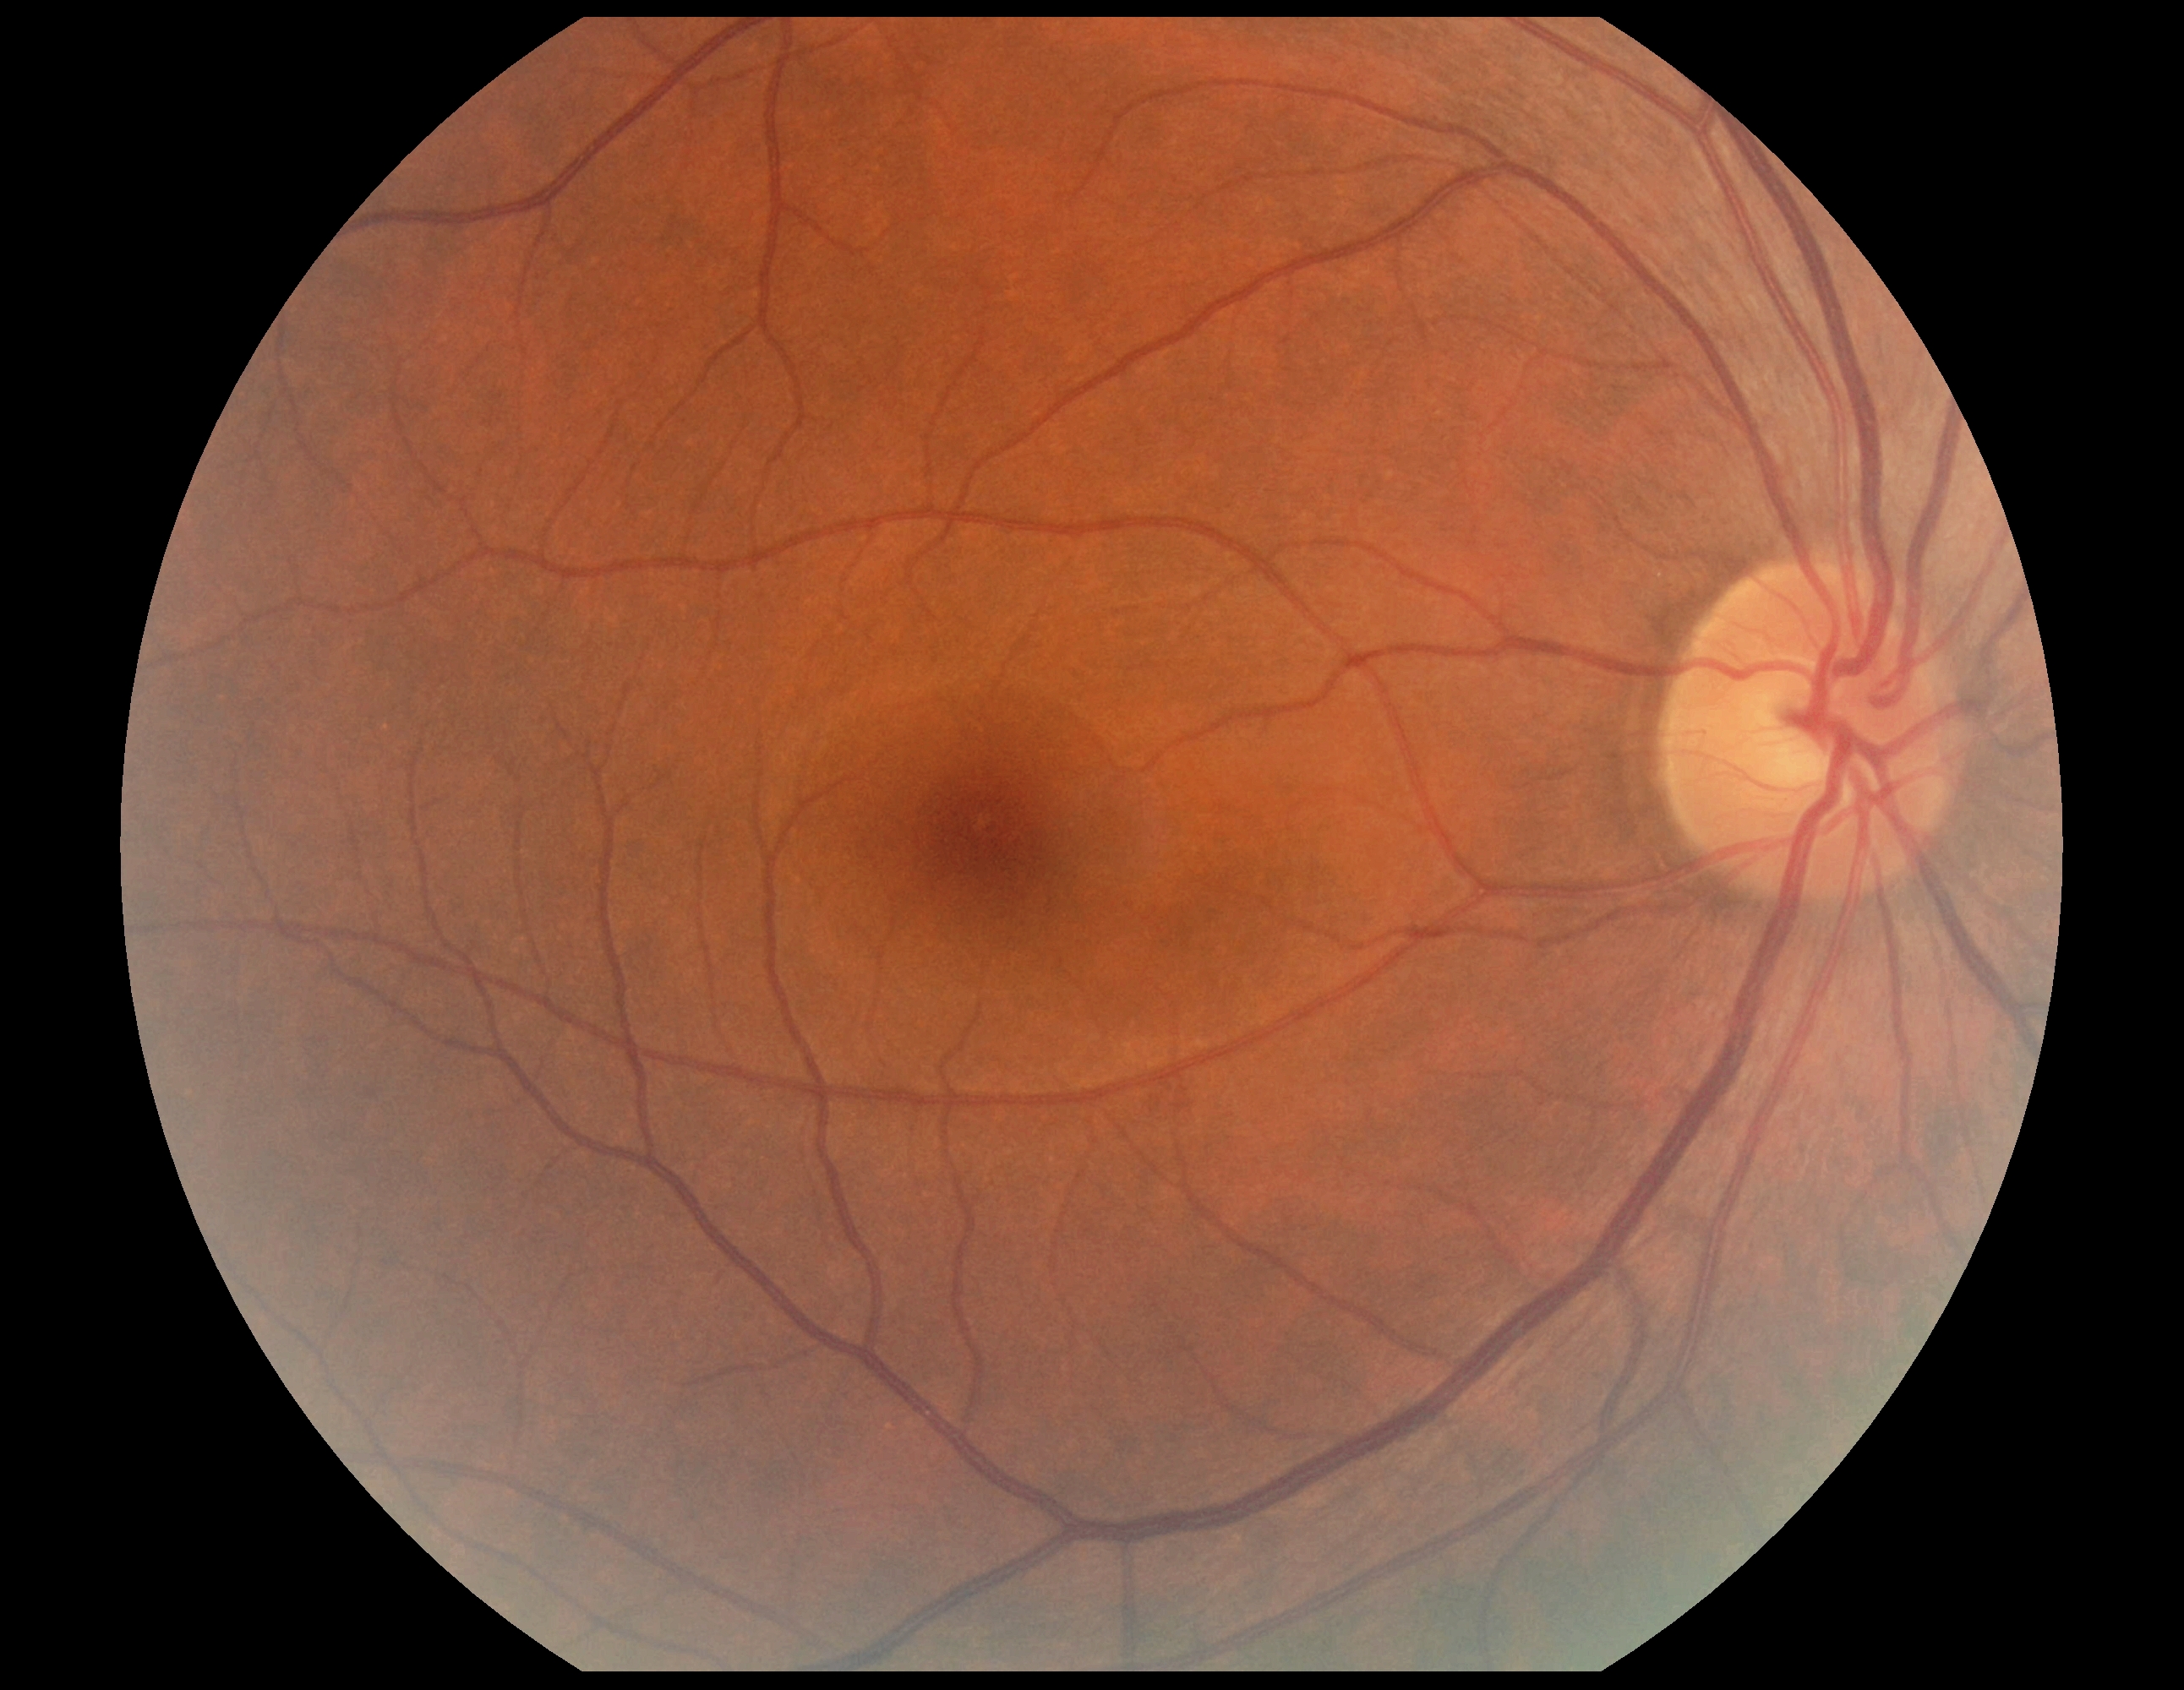

diabetic retinopathy severity@grade 0.